RetCam wide-field infant fundus image. Image size 640x480:
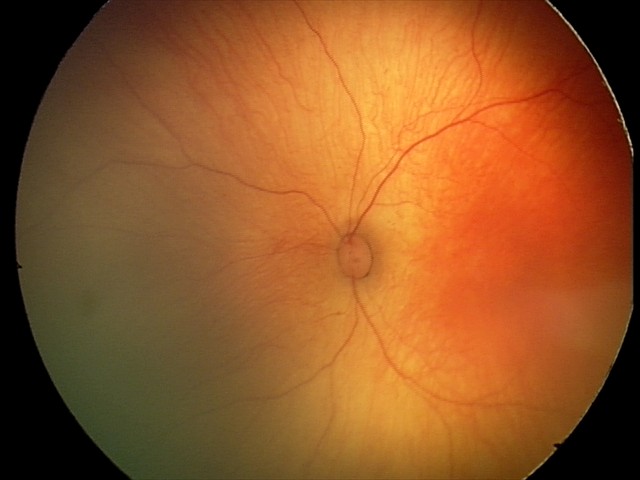

Physiological retinal appearance for postconceptual age.